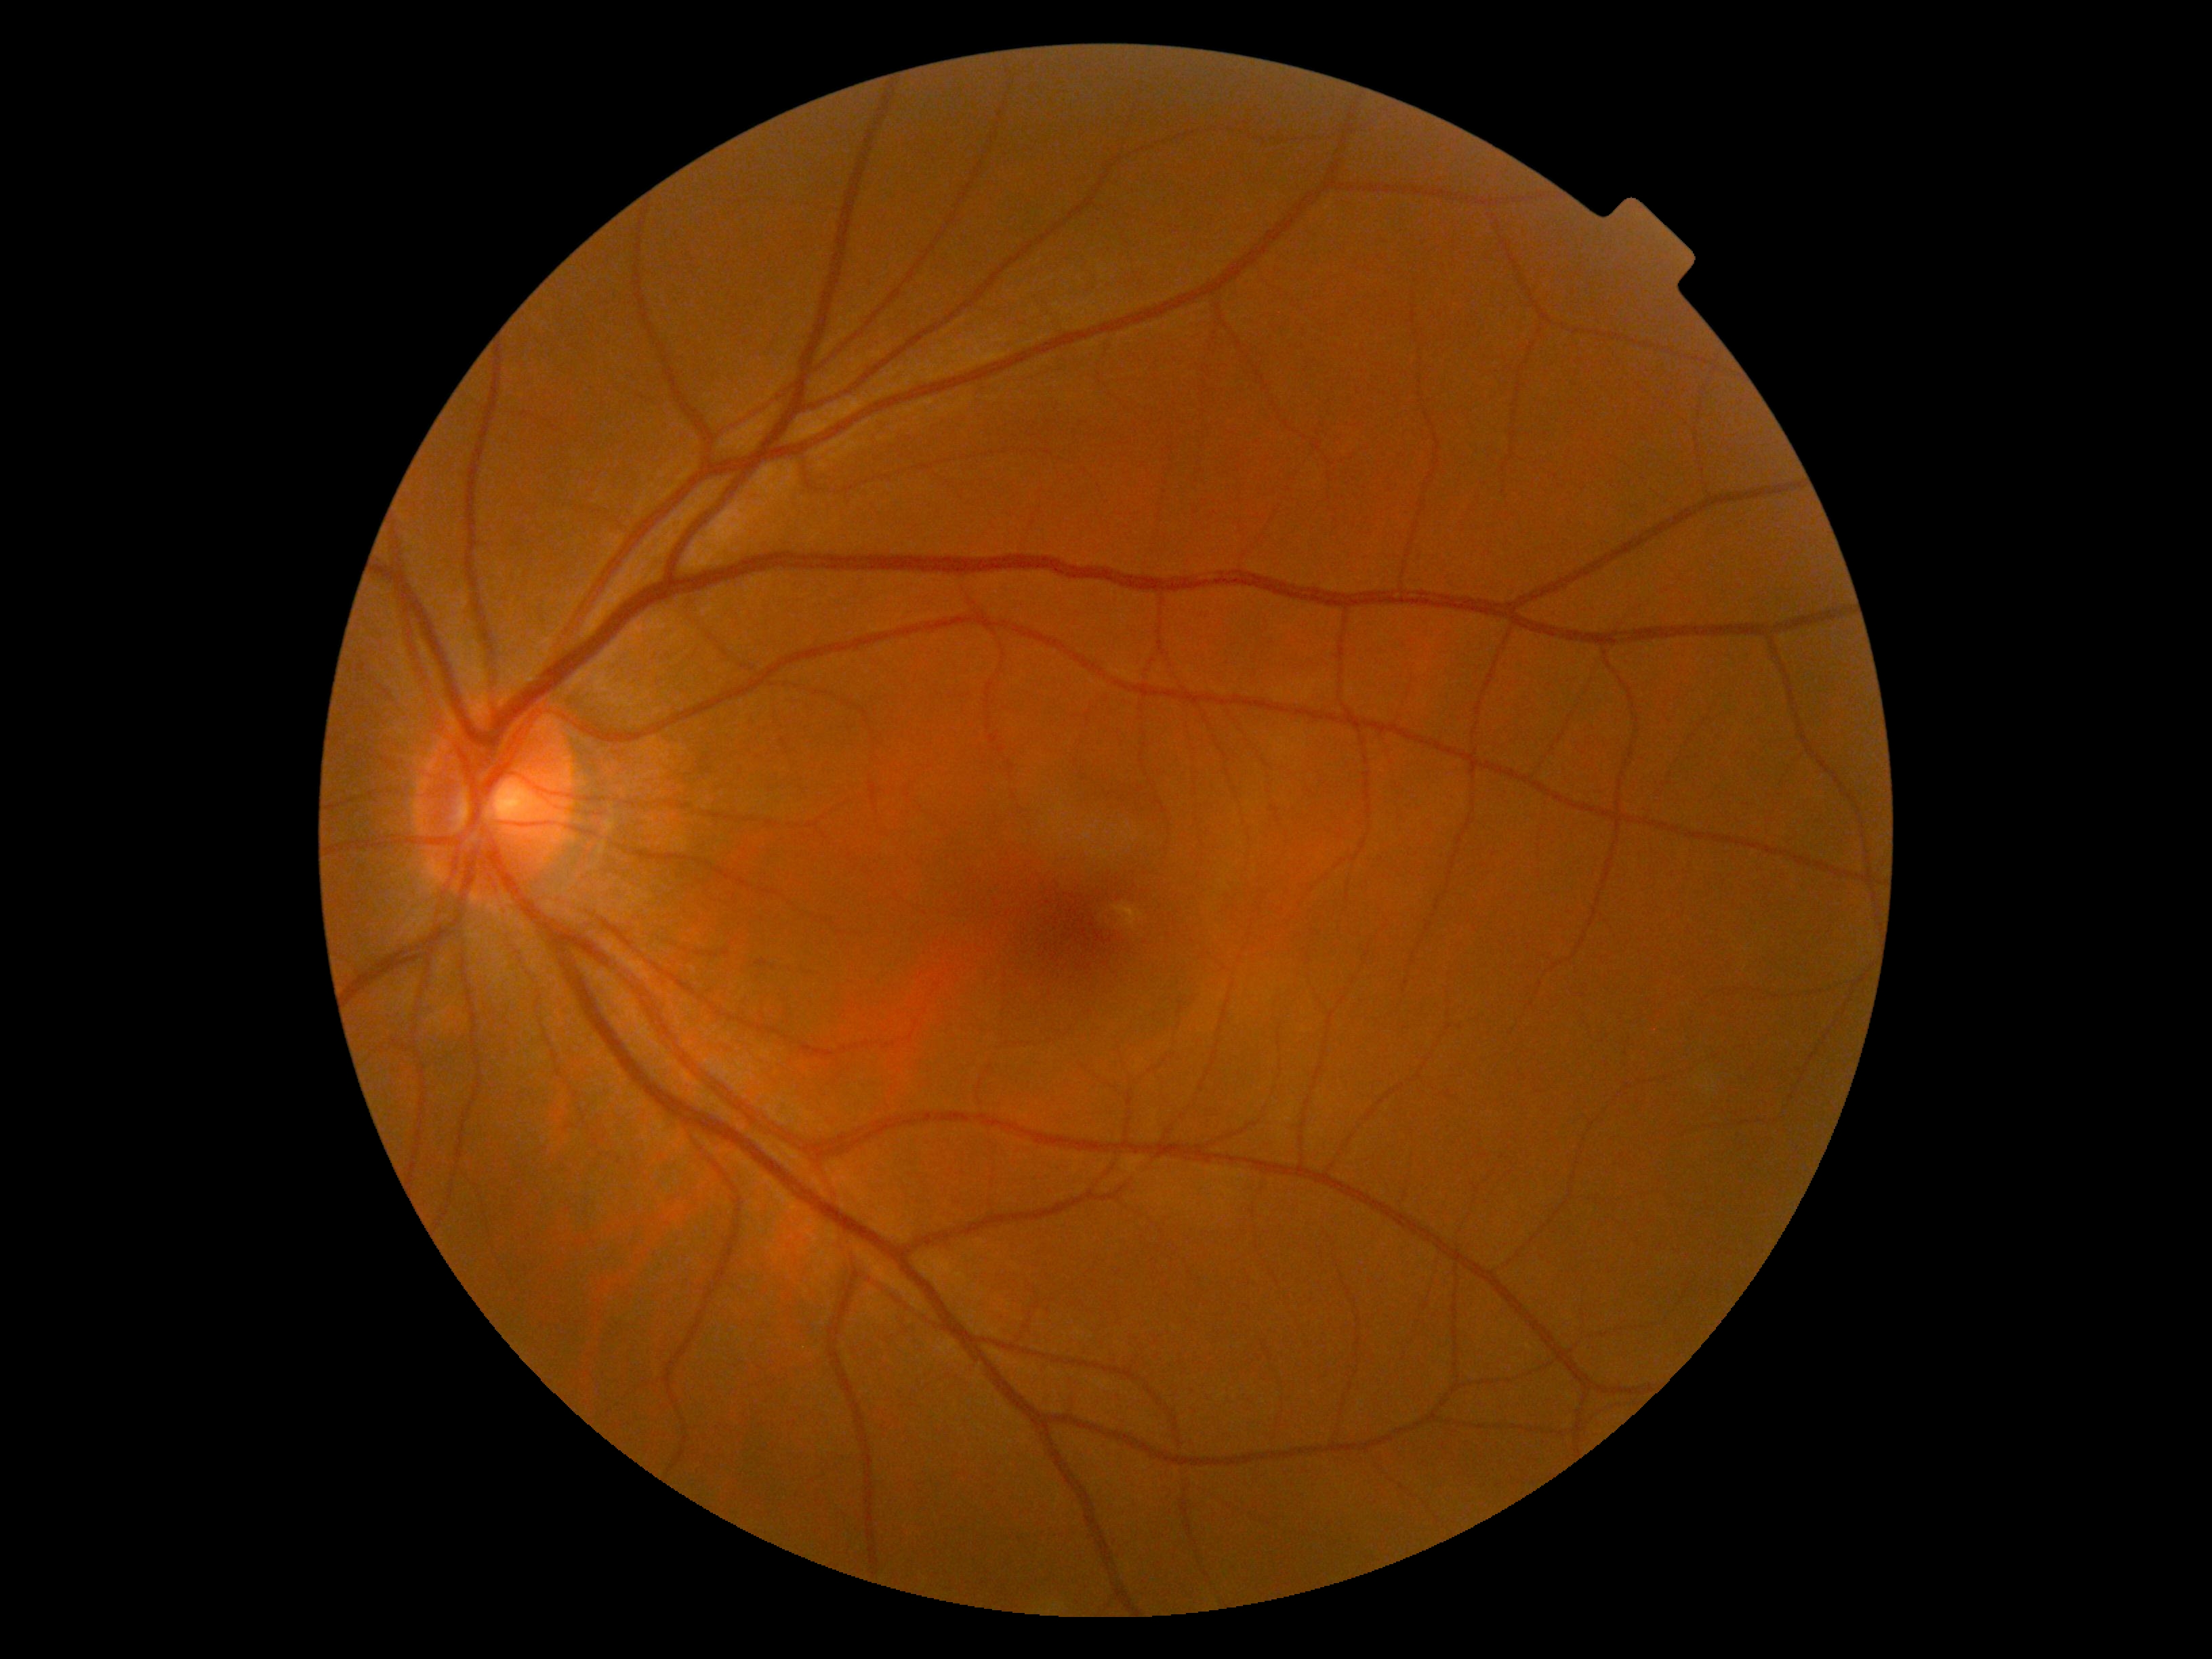

DR: grade 0 — no visible signs of diabetic retinopathy.